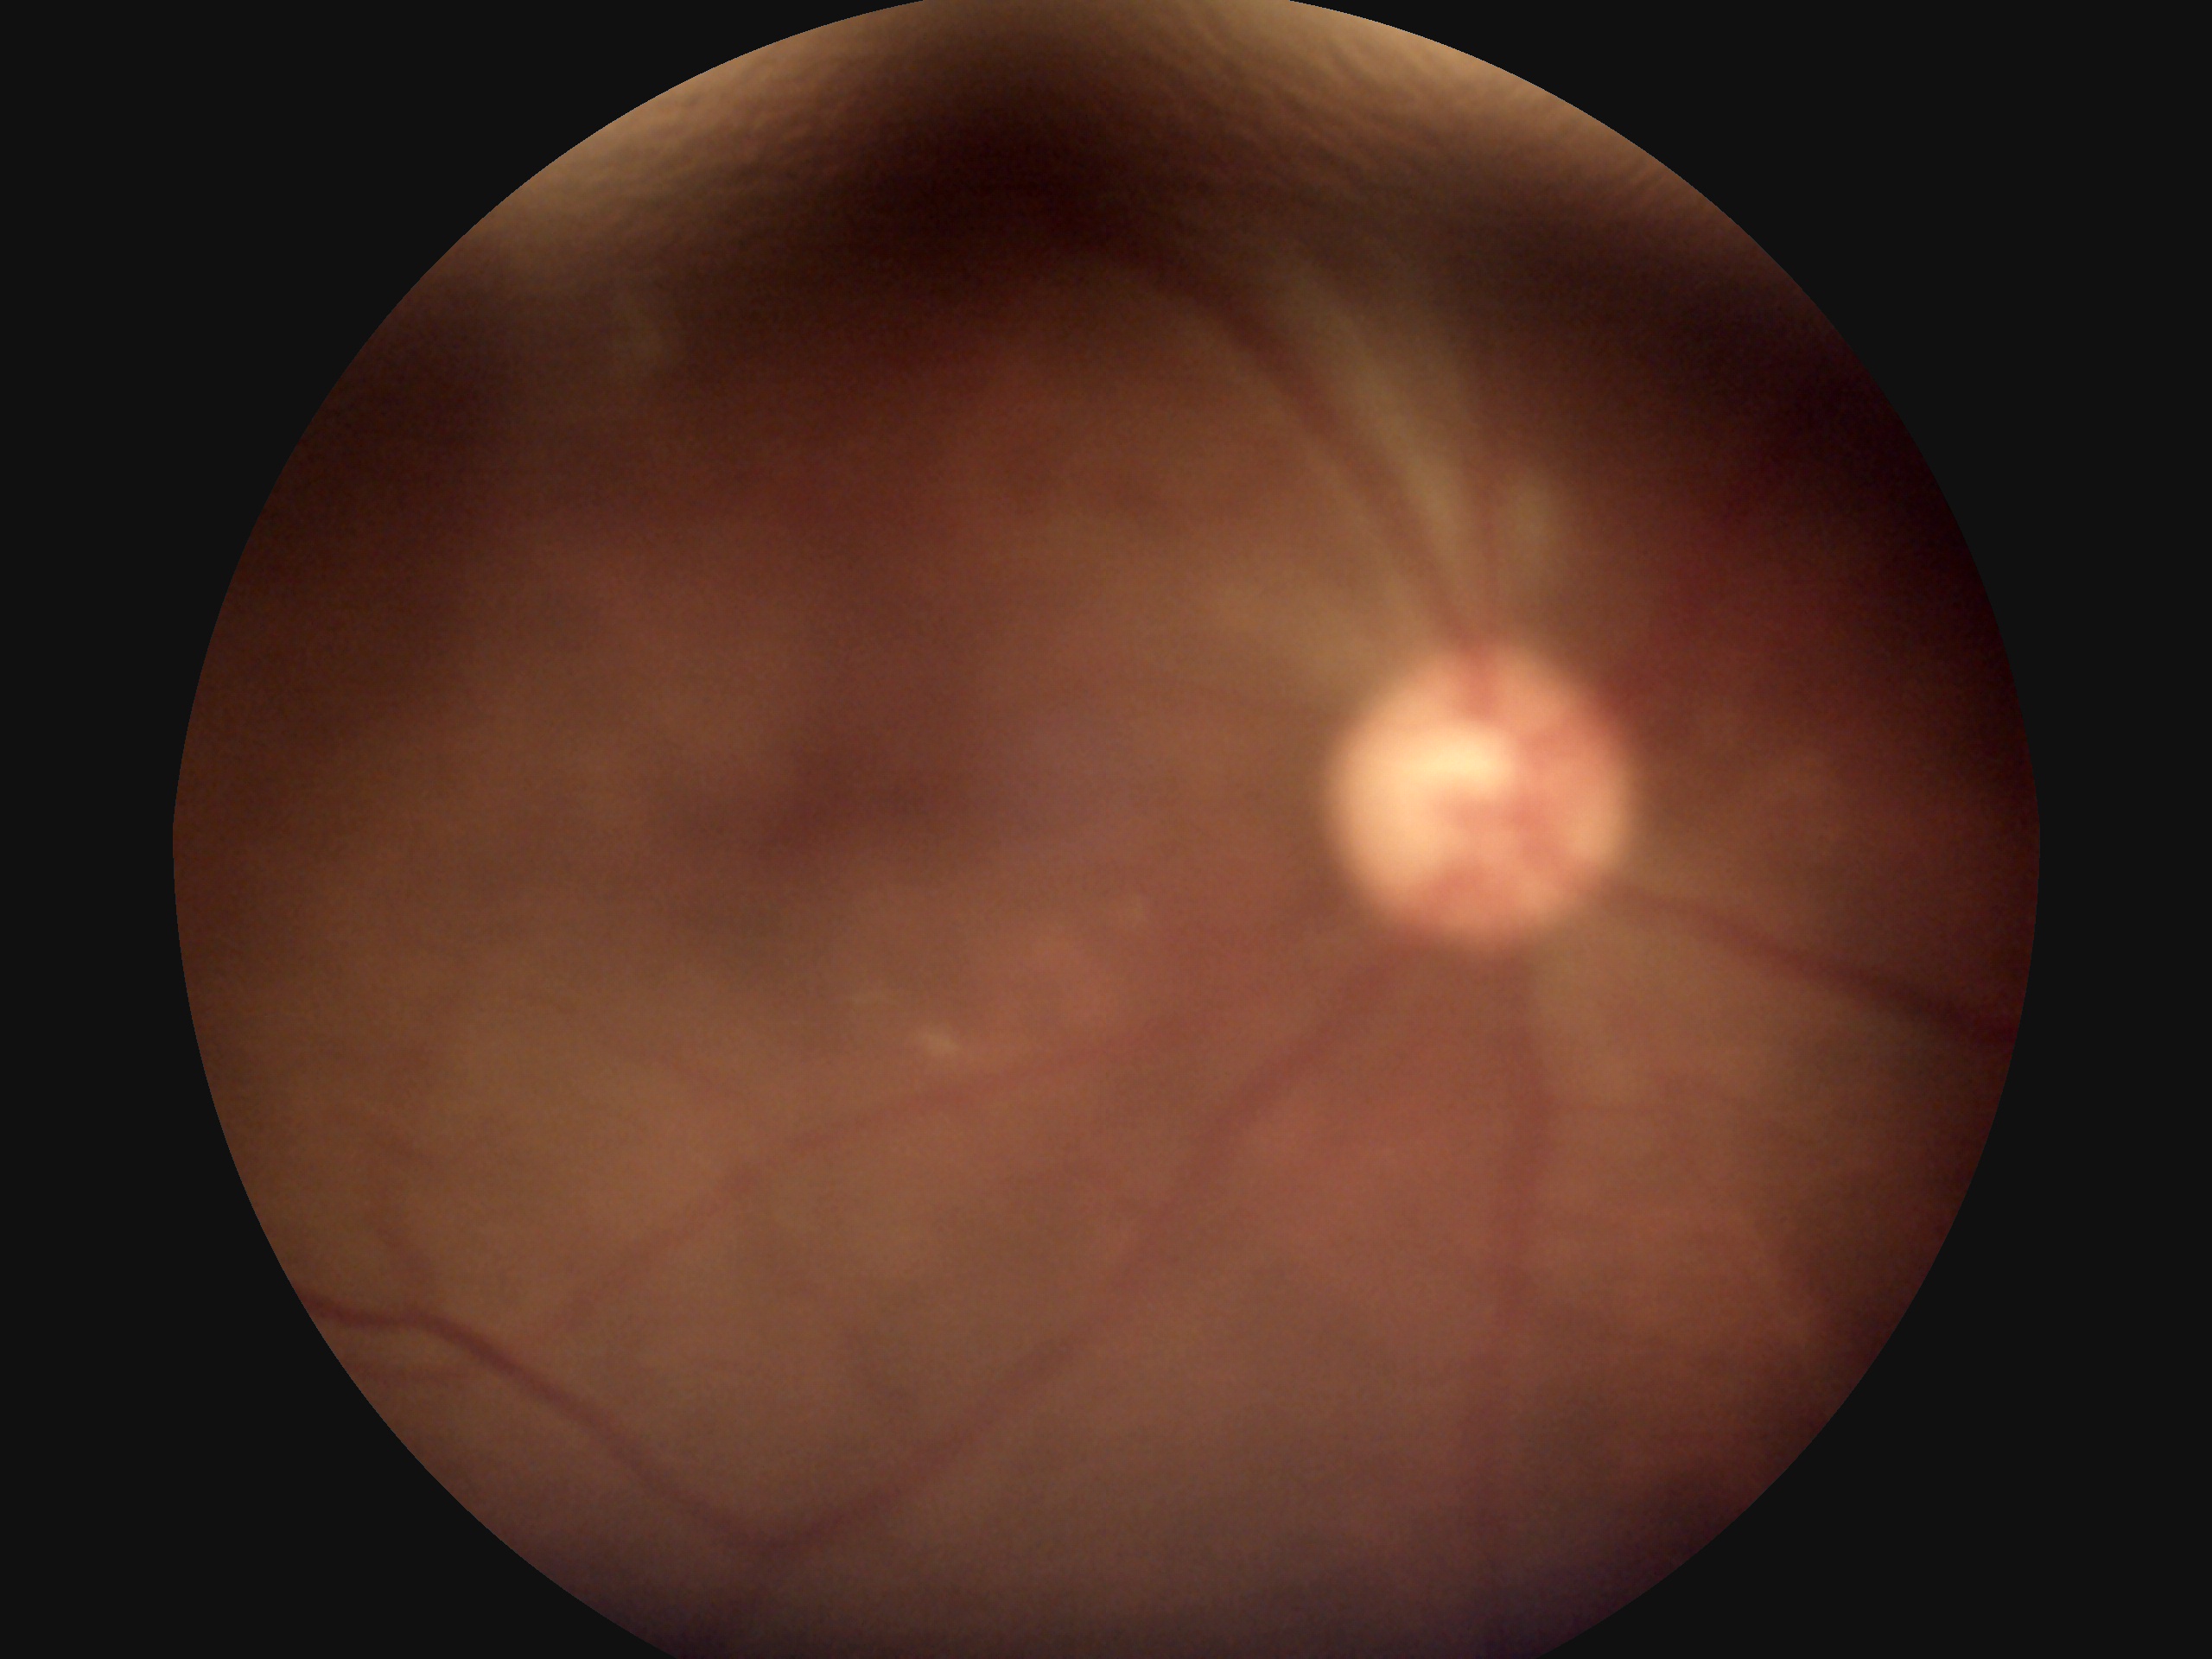 DR severity: 0.